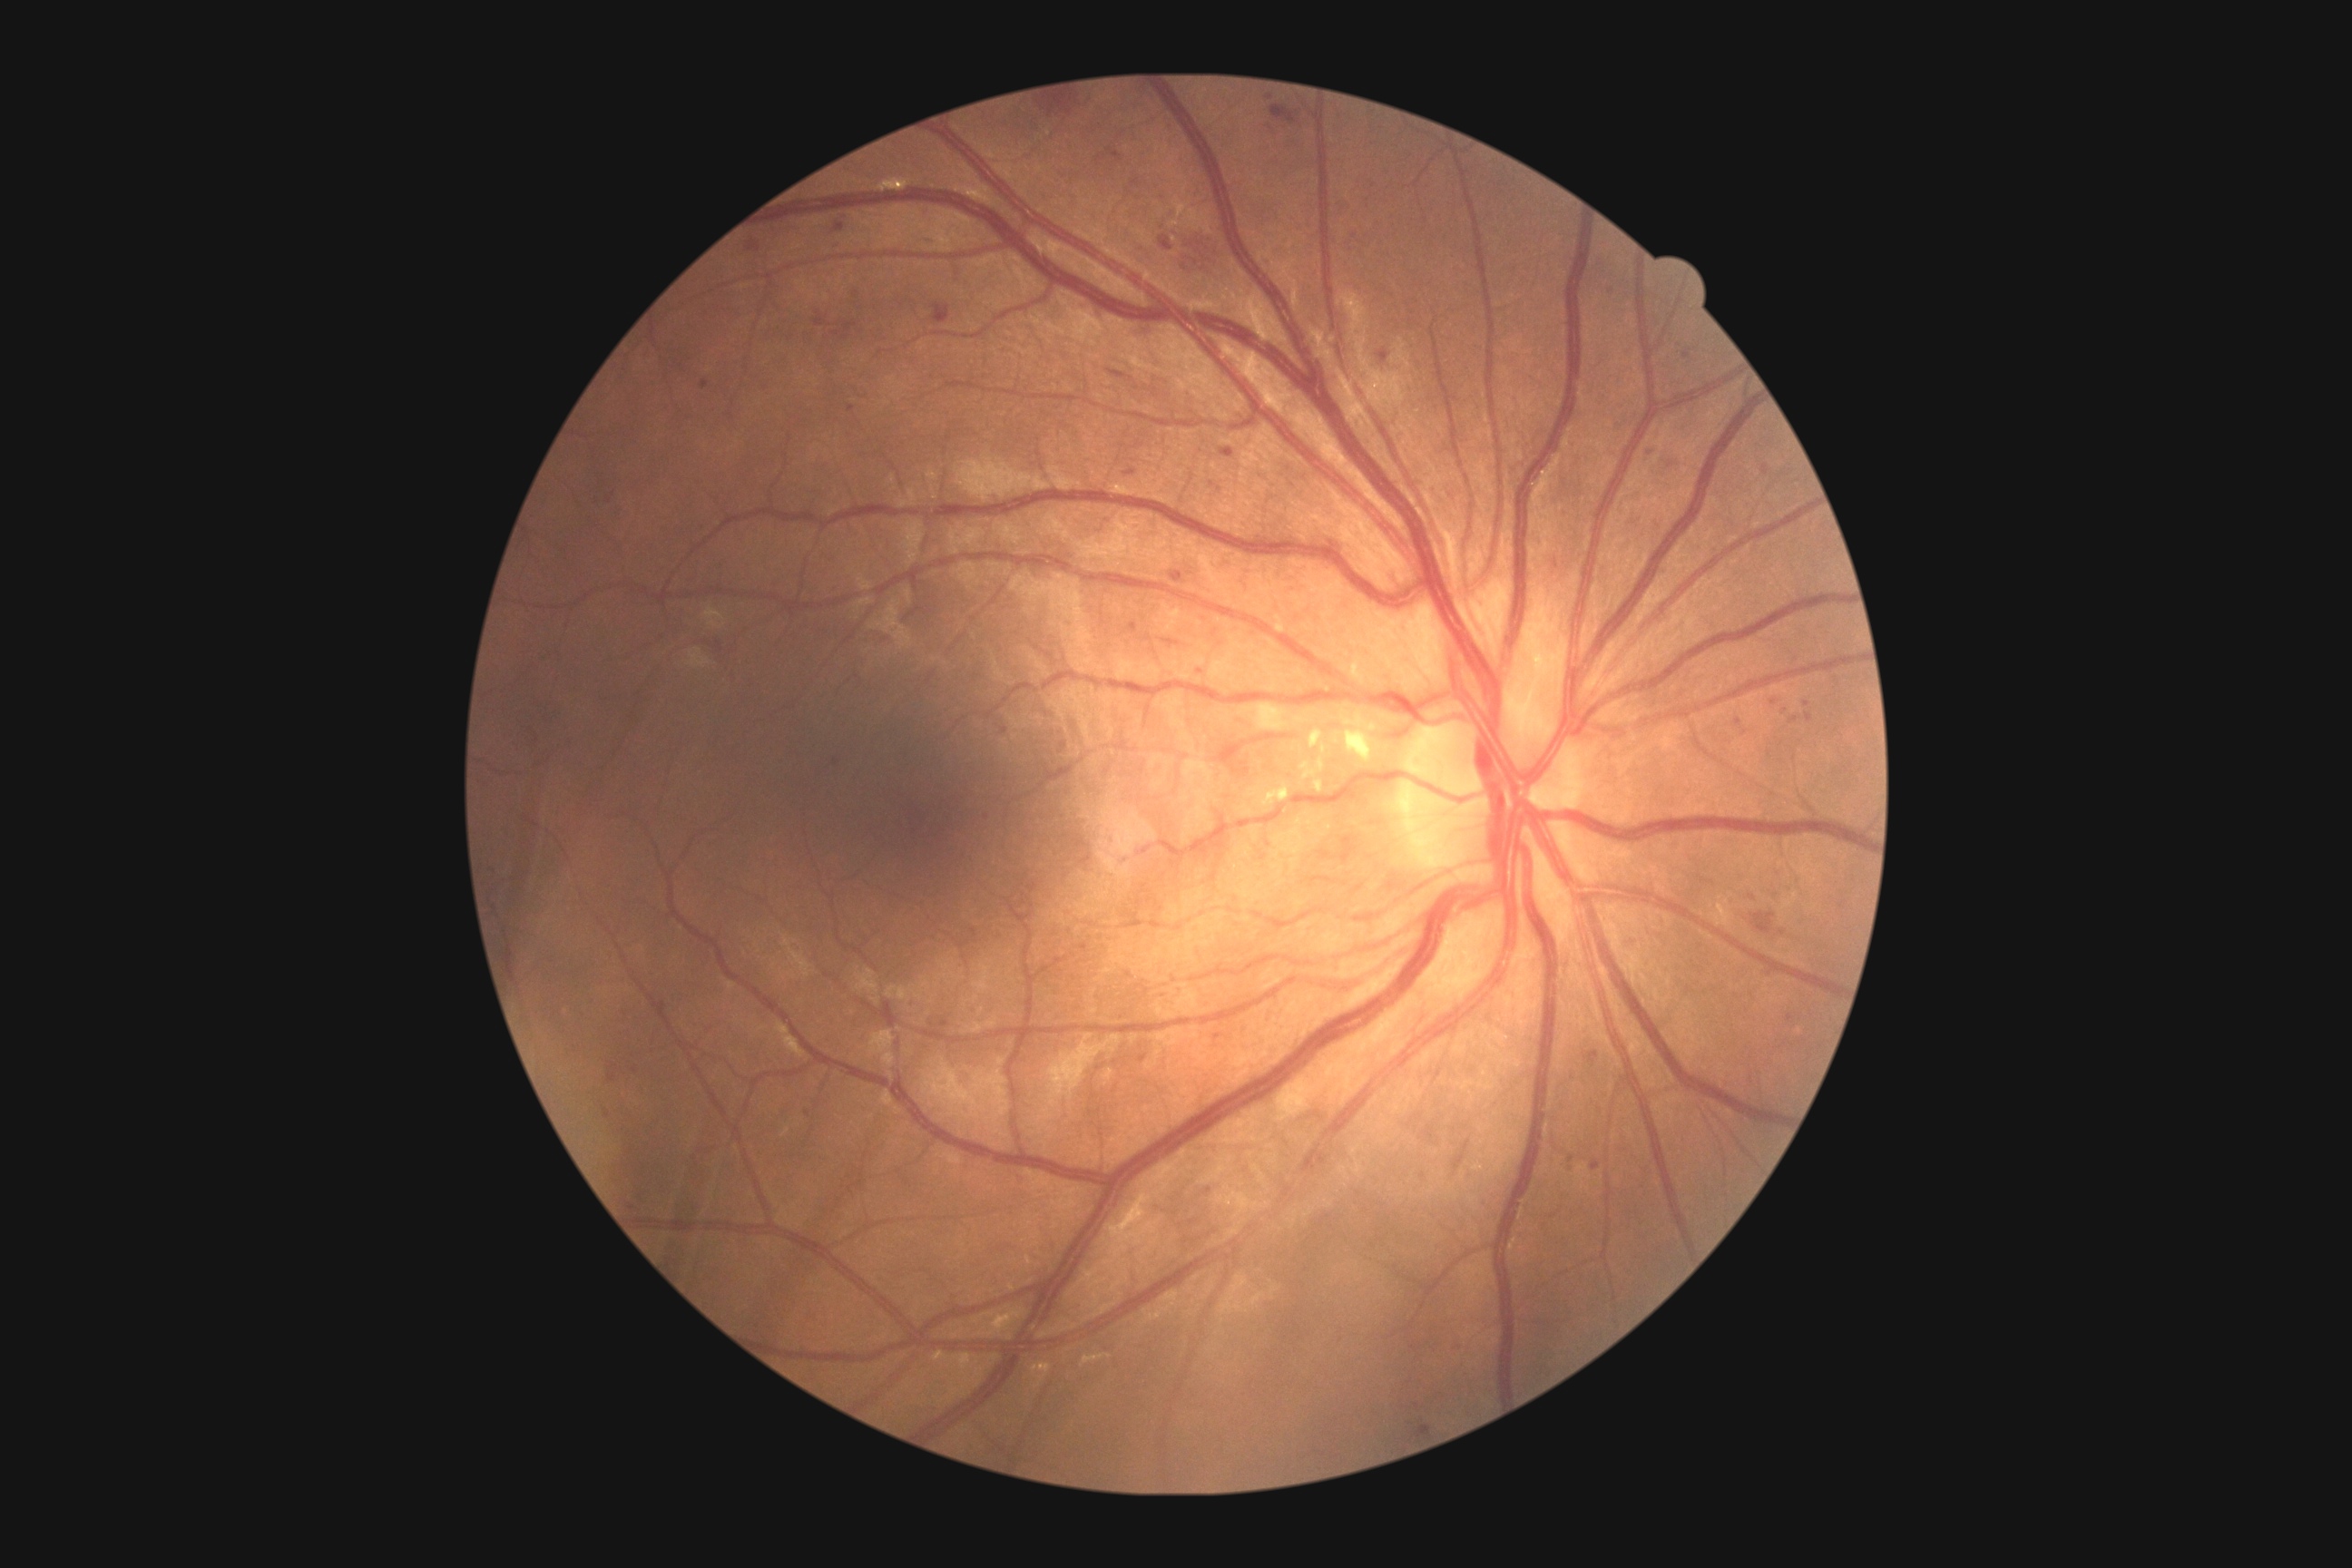 DR is 2/4.